Image size 848x848 · NIDEK AFC-230 fundus camera · retinal fundus photograph · FOV: 45 degrees · modified Davis grading — 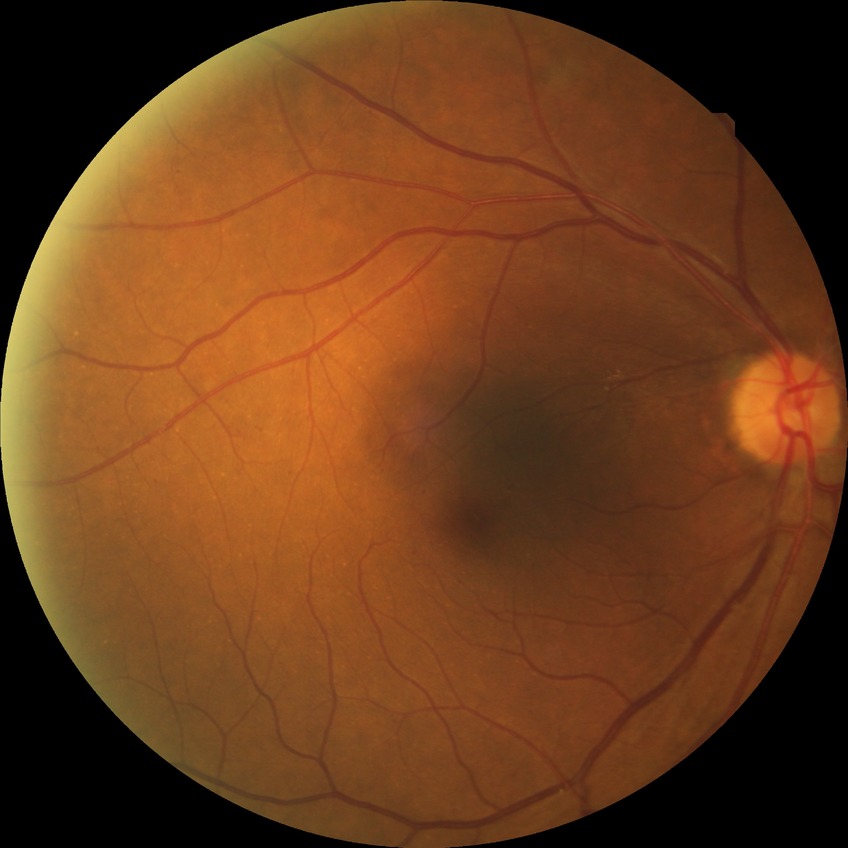 DR is SDR.